Macula-centered, fundus photo:
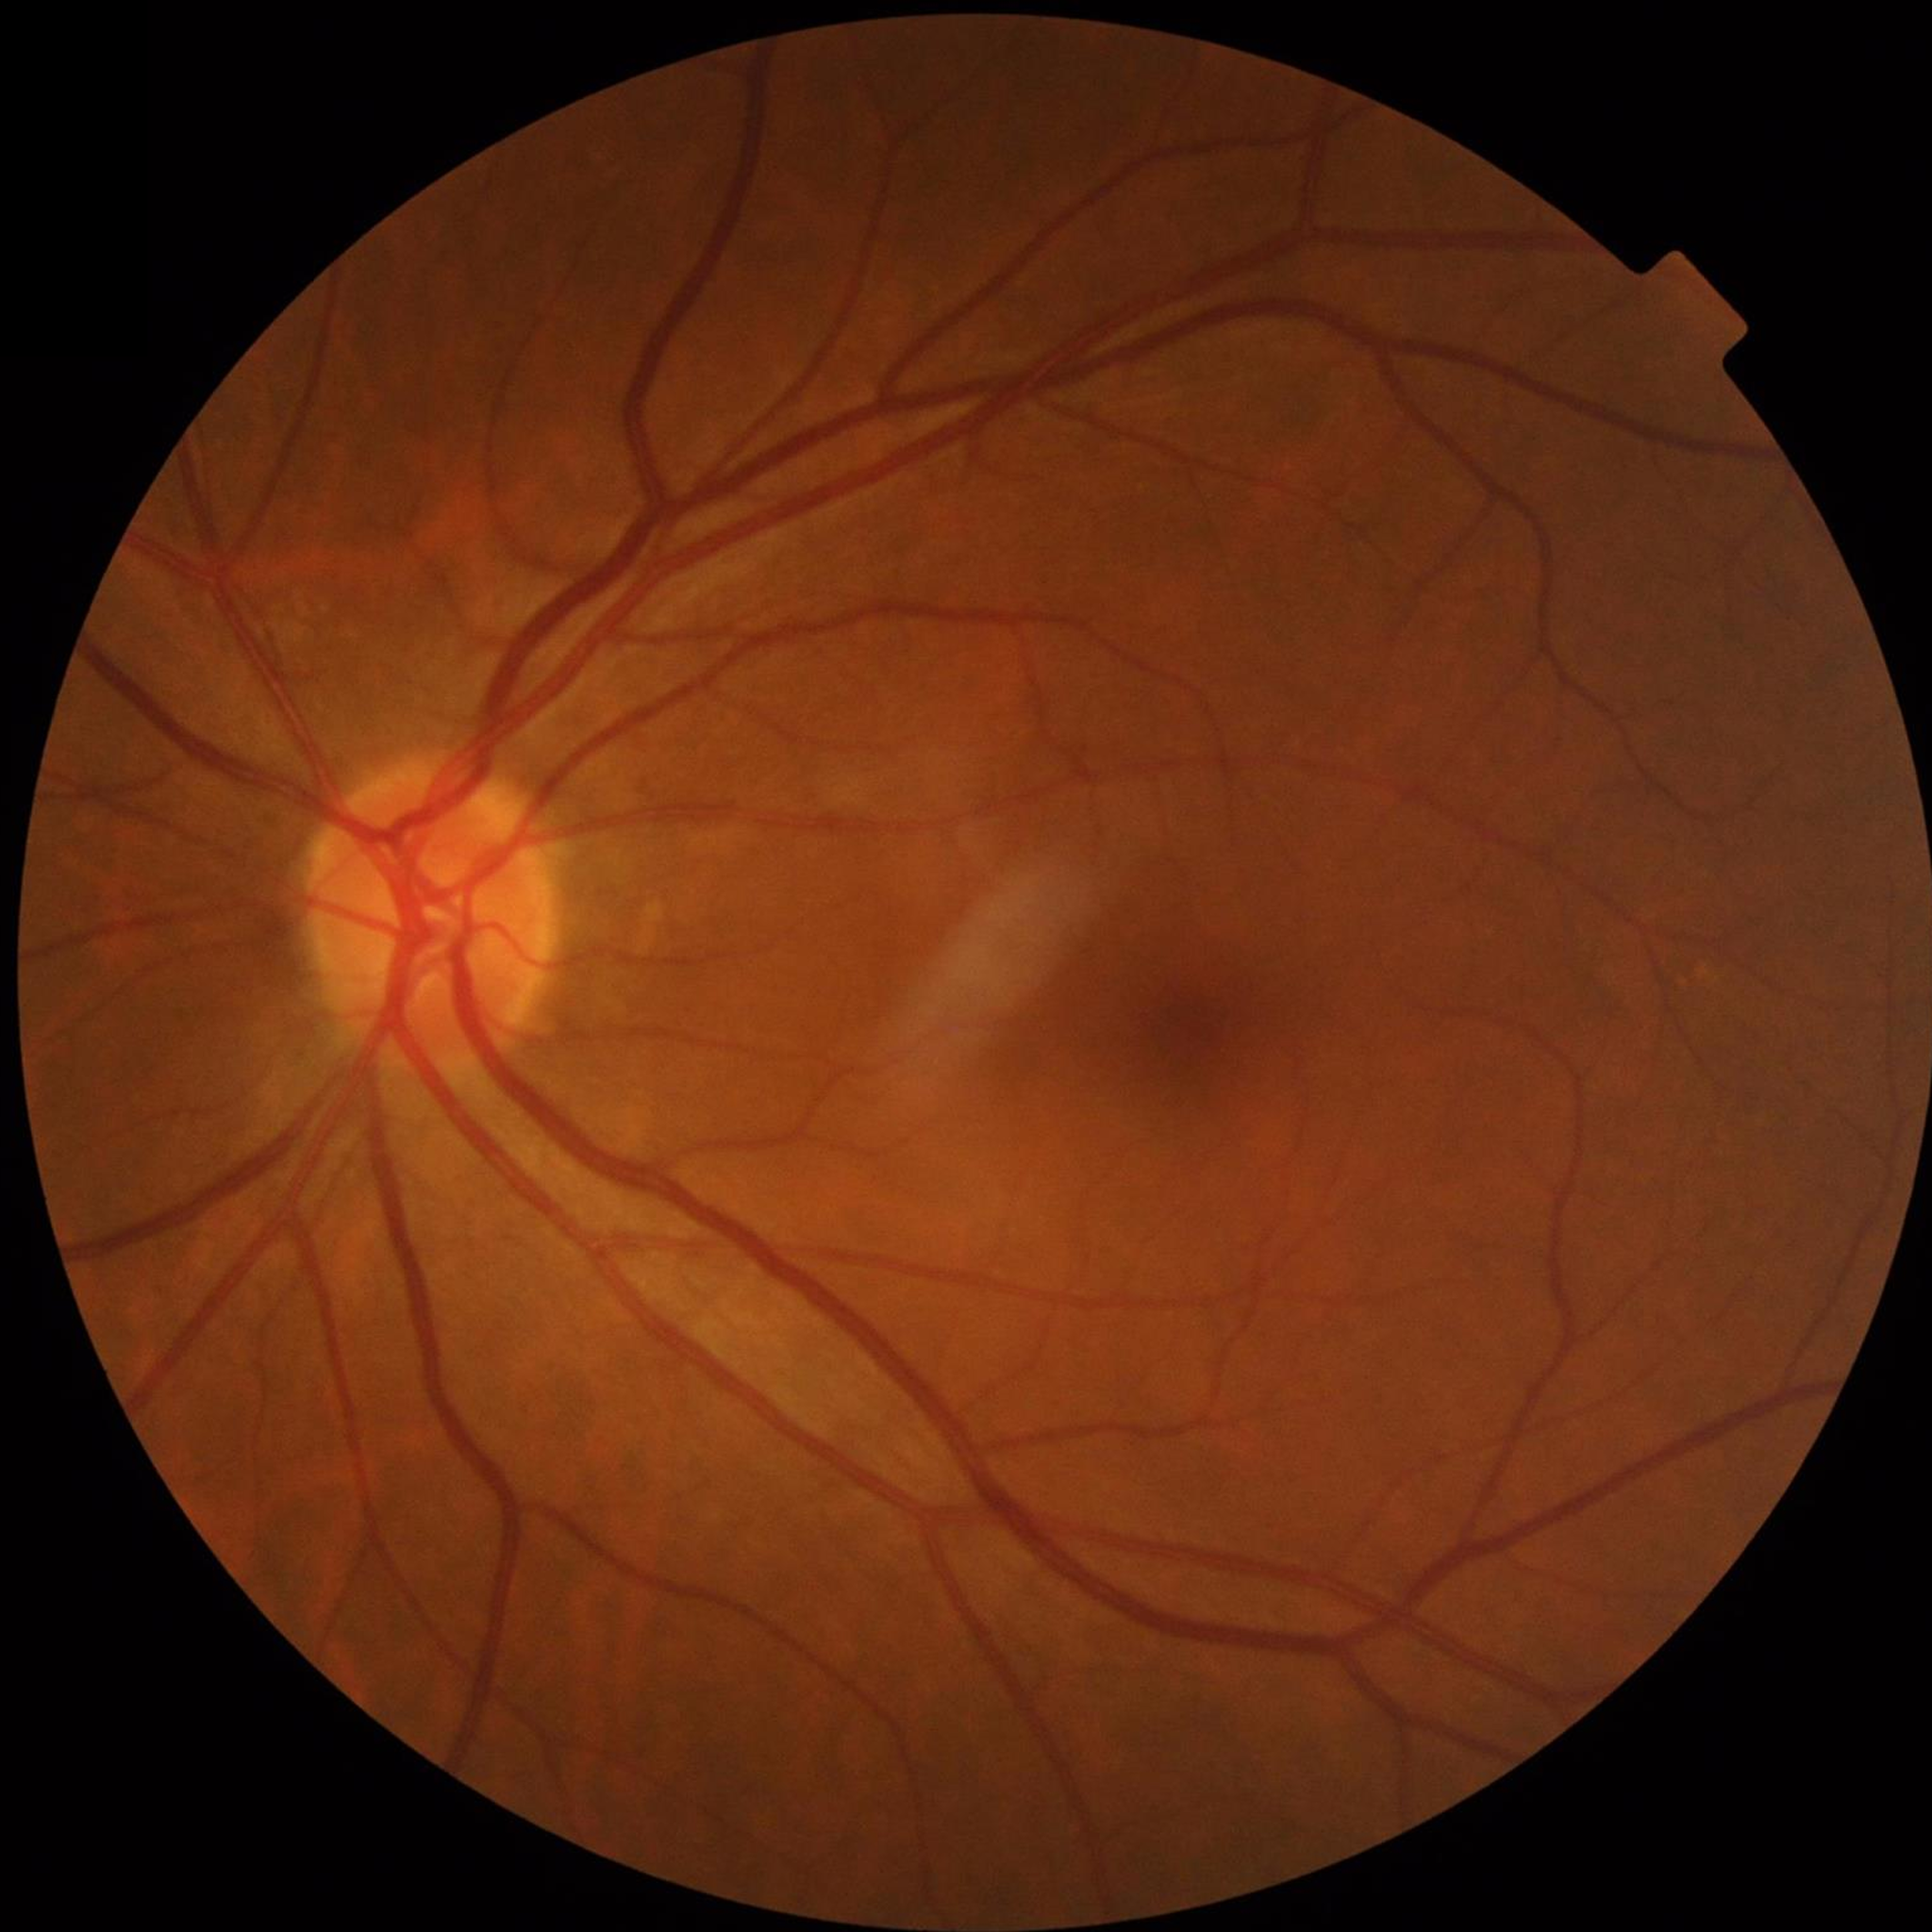
No findings of AMD, diabetic retinopathy, or glaucoma.